Davis DR grading, NIDEK AFC-230, nonmydriatic fundus photograph.
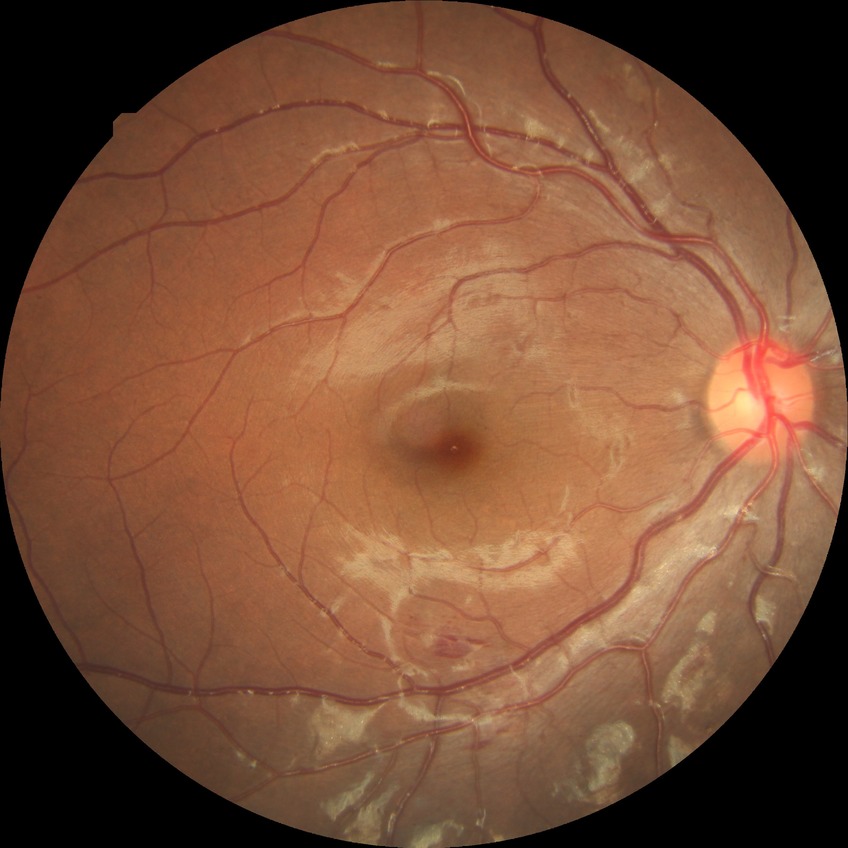
Modified Davis classification is simple diabetic retinopathy.